Diabetic retinopathy graded by the modified Davis classification
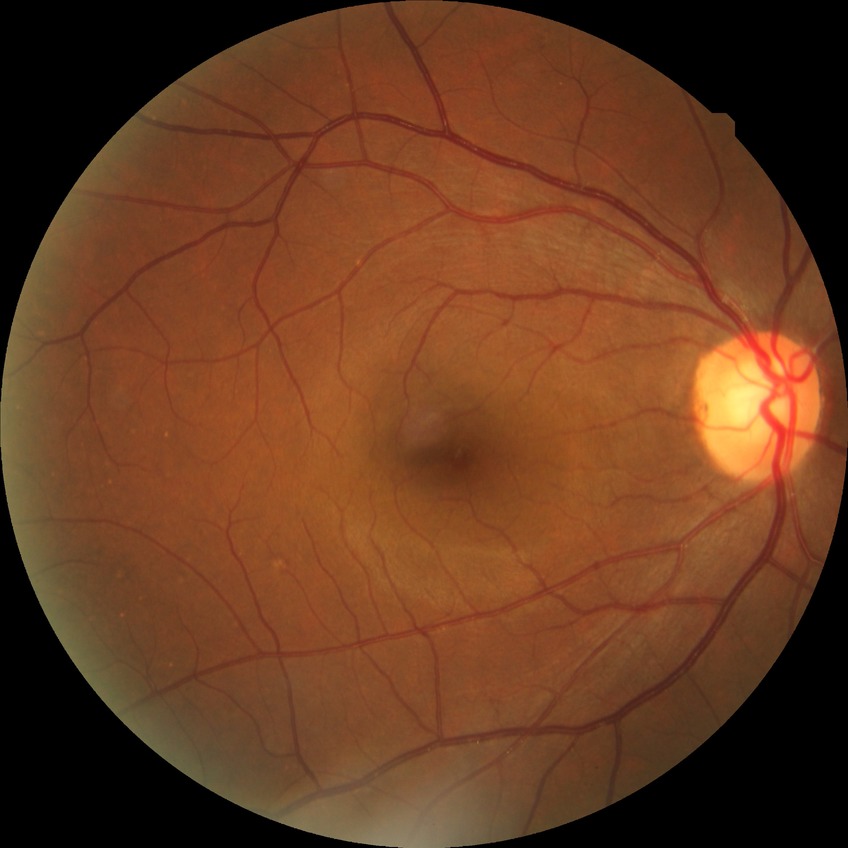
diabetic retinopathy (DR) = NDR (no diabetic retinopathy).